2048x1536px · 45° field of view — 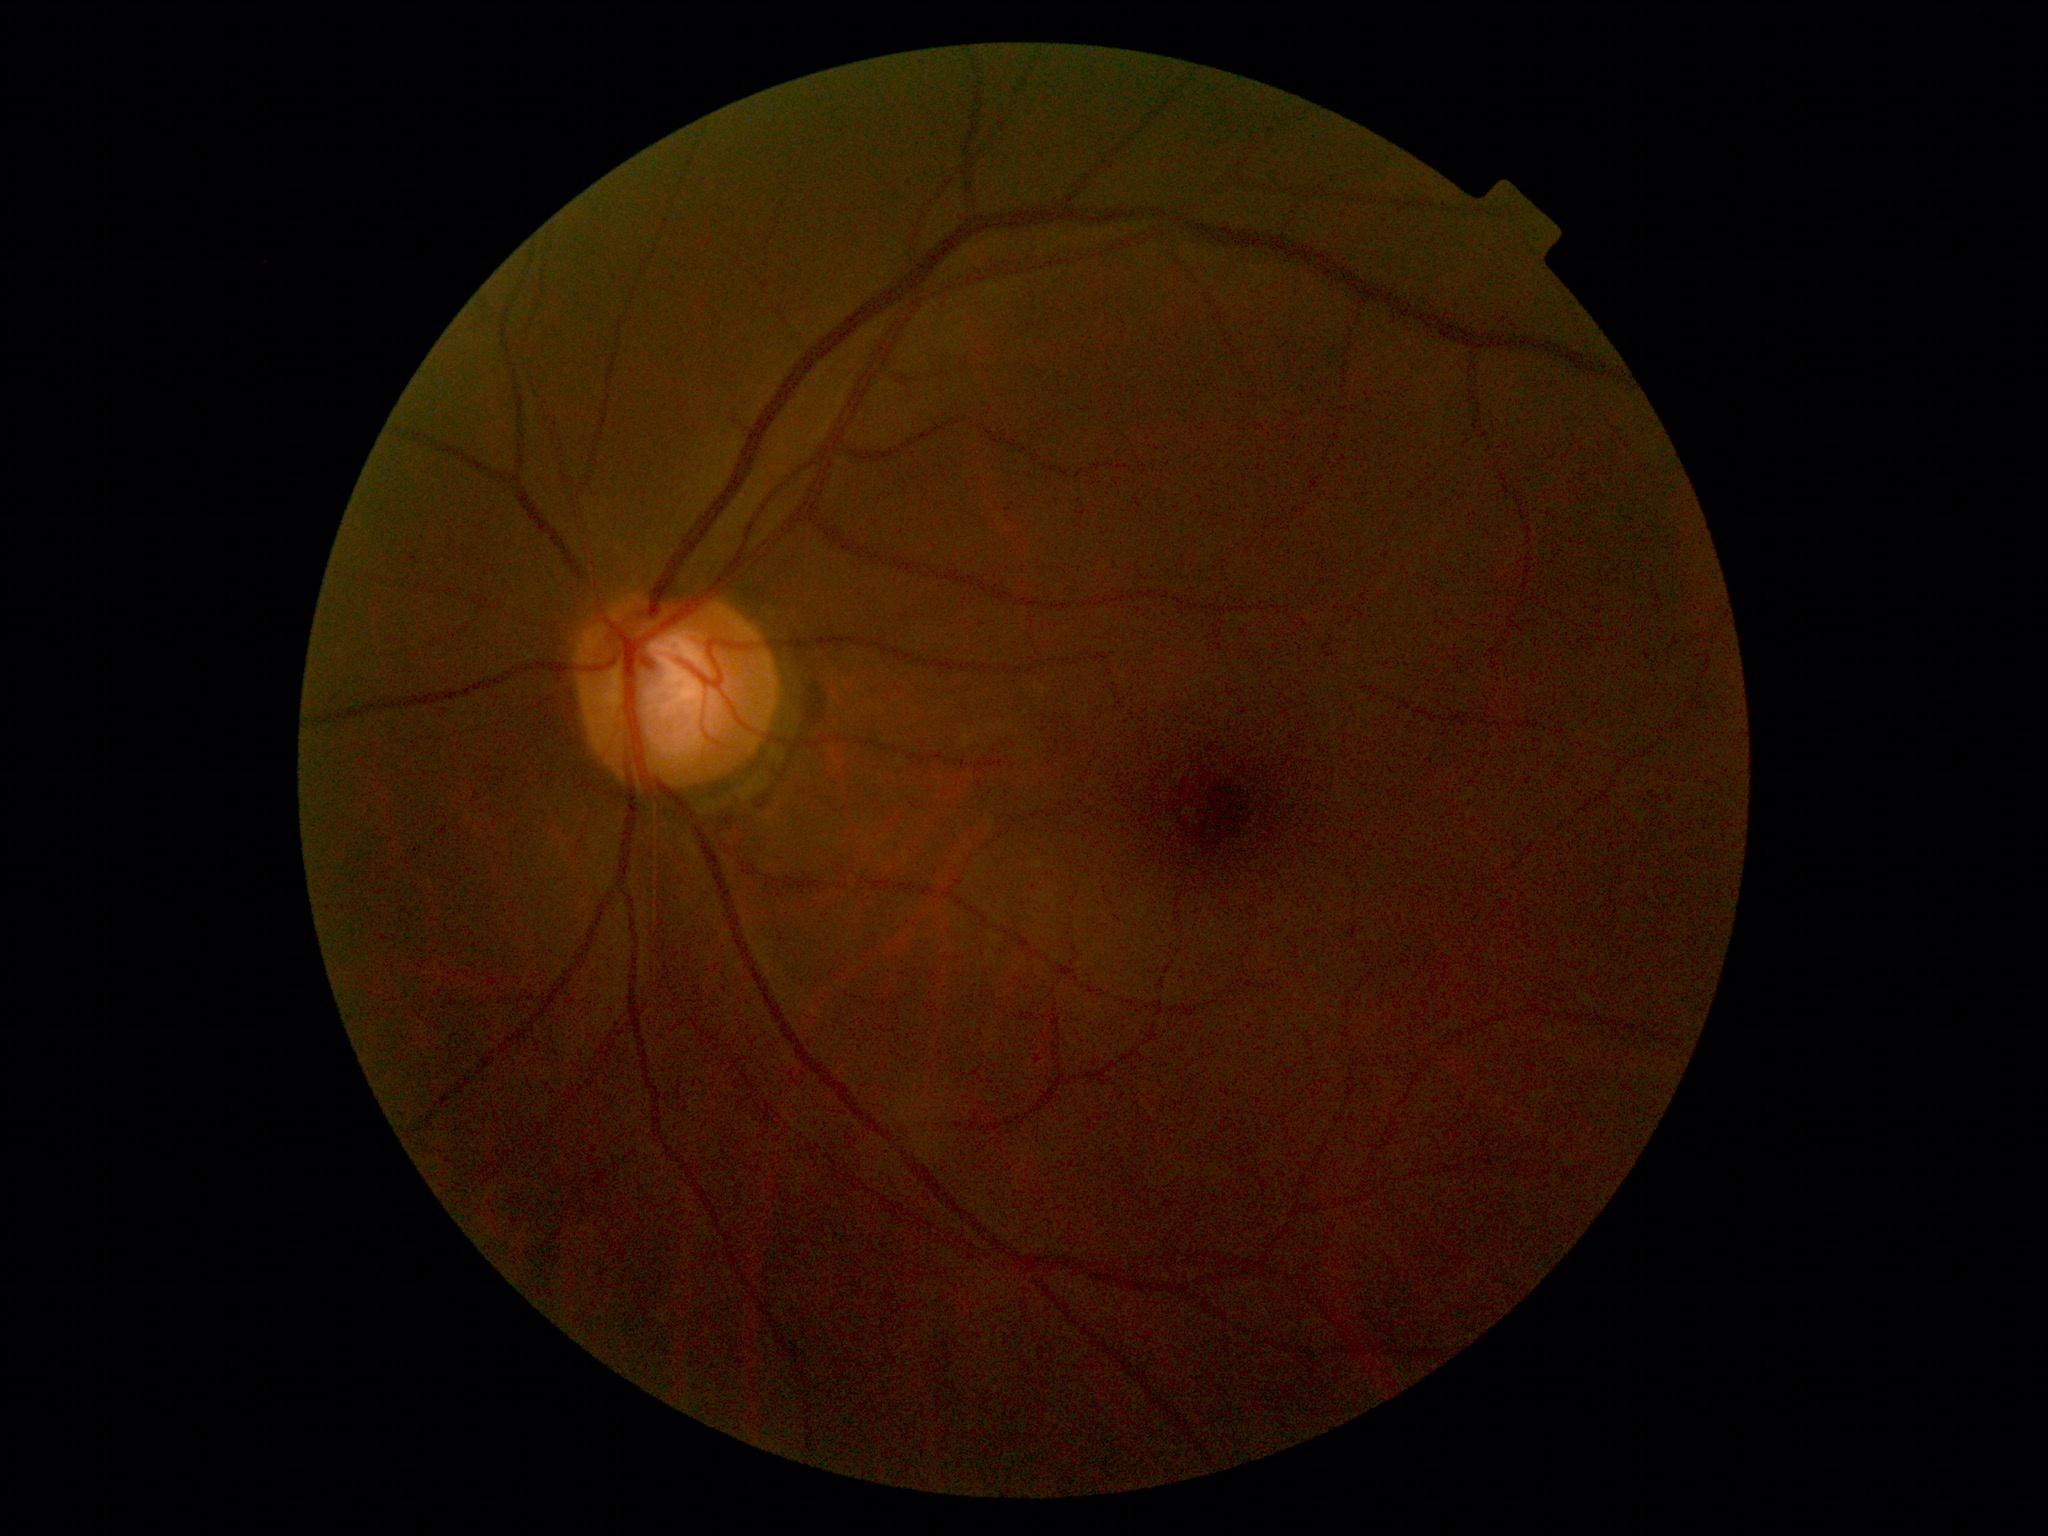 DR impression: no signs of DR; diabetic retinopathy severity: grade 0.